45-degree field of view. Fundus photo: 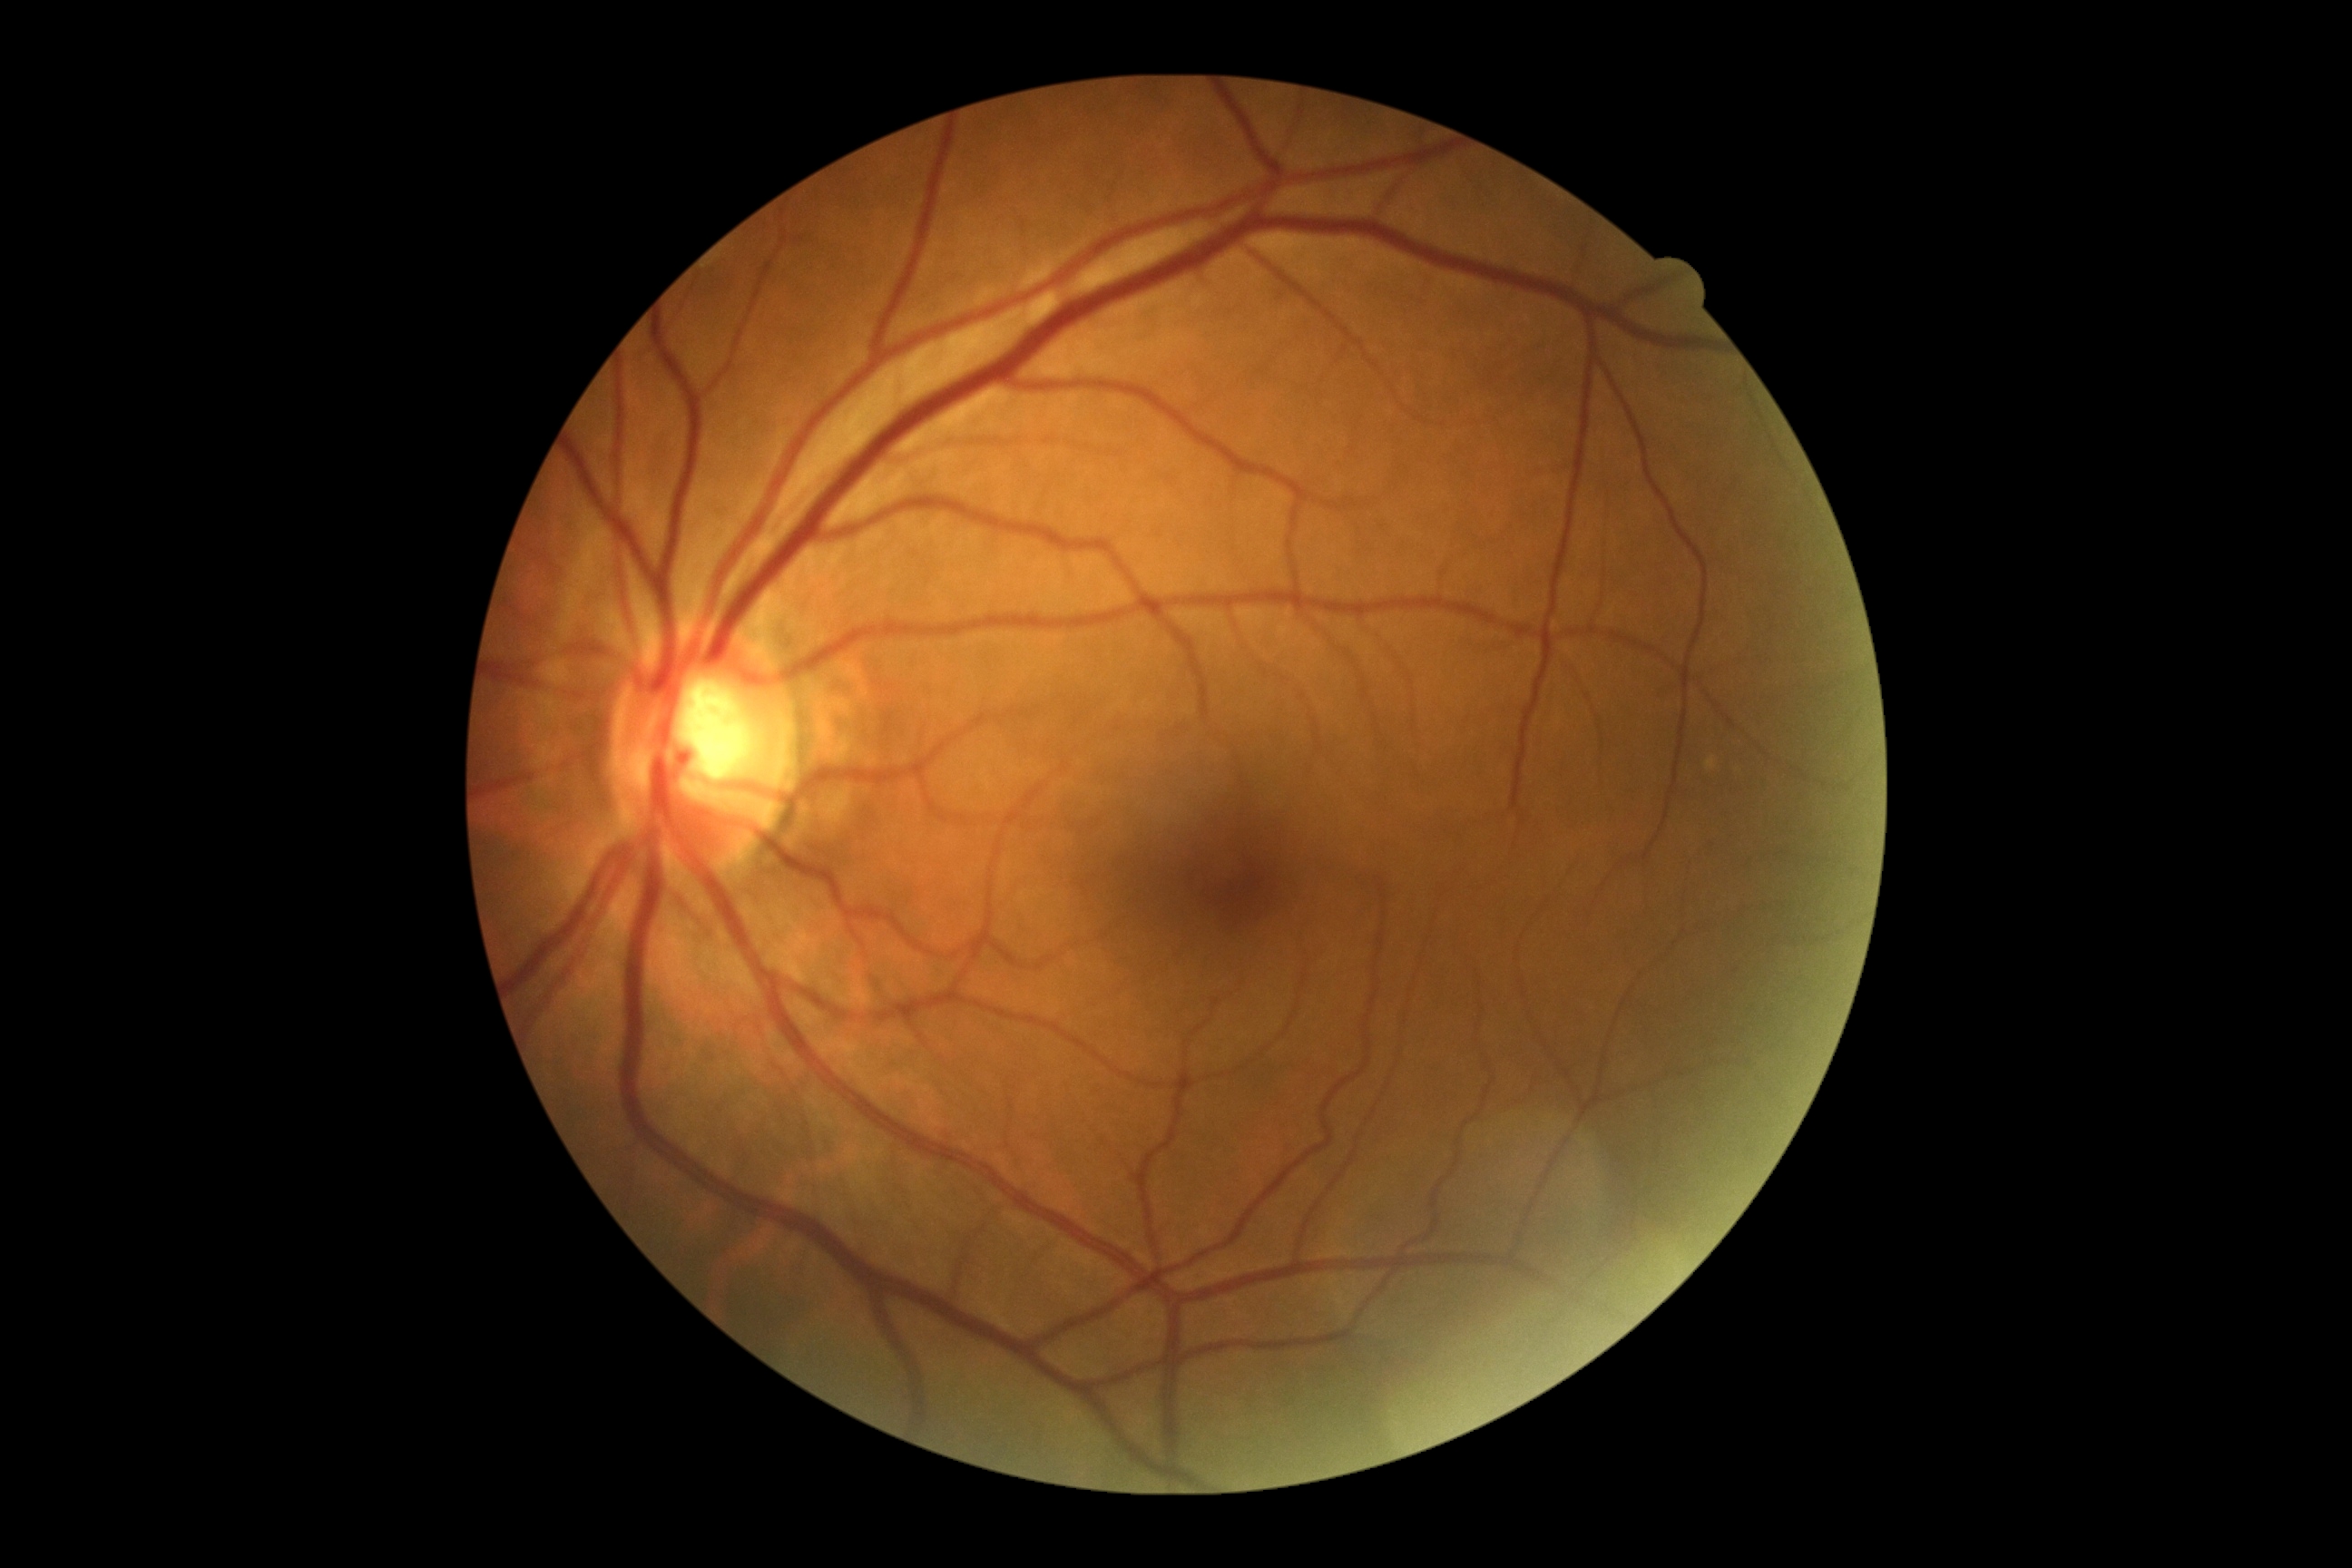 DR severity: grade 0 (no apparent retinopathy).
No DR findings.